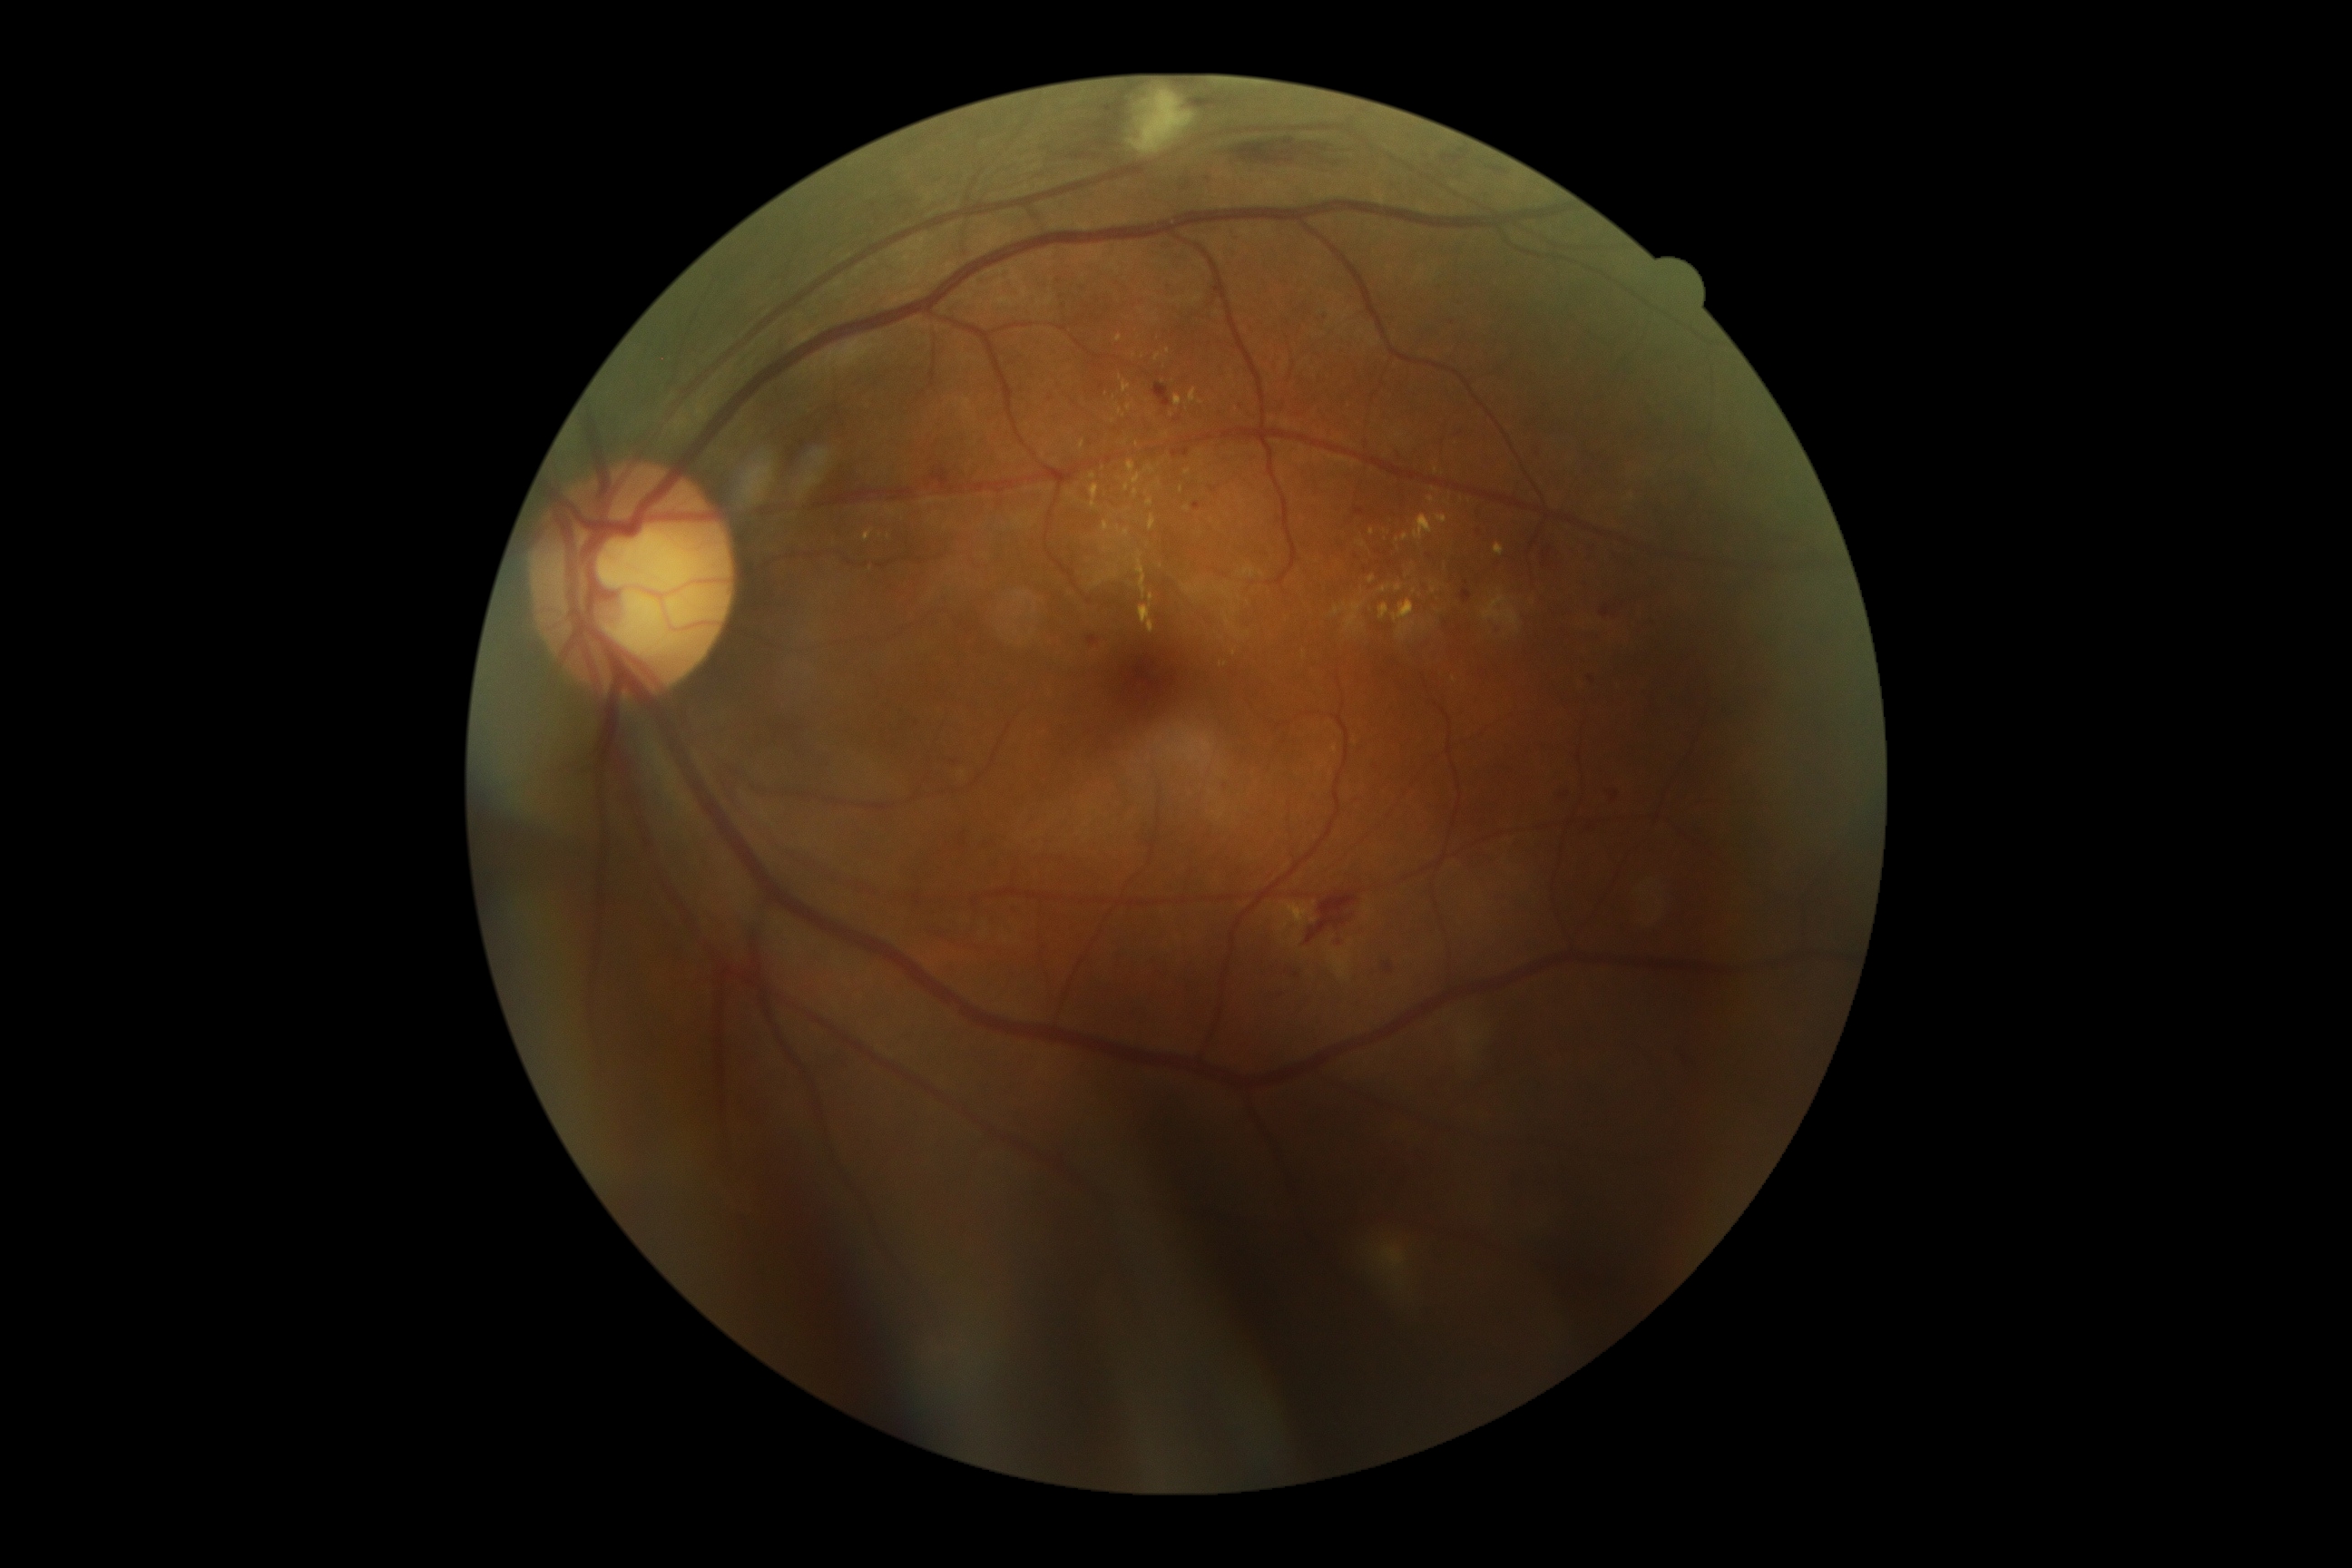
  dr_grade: moderate NPDR (grade 2) — more than just microaneurysms but less than severe NPDR